Captured on a Remidio FOP fundus camera; color fundus image: 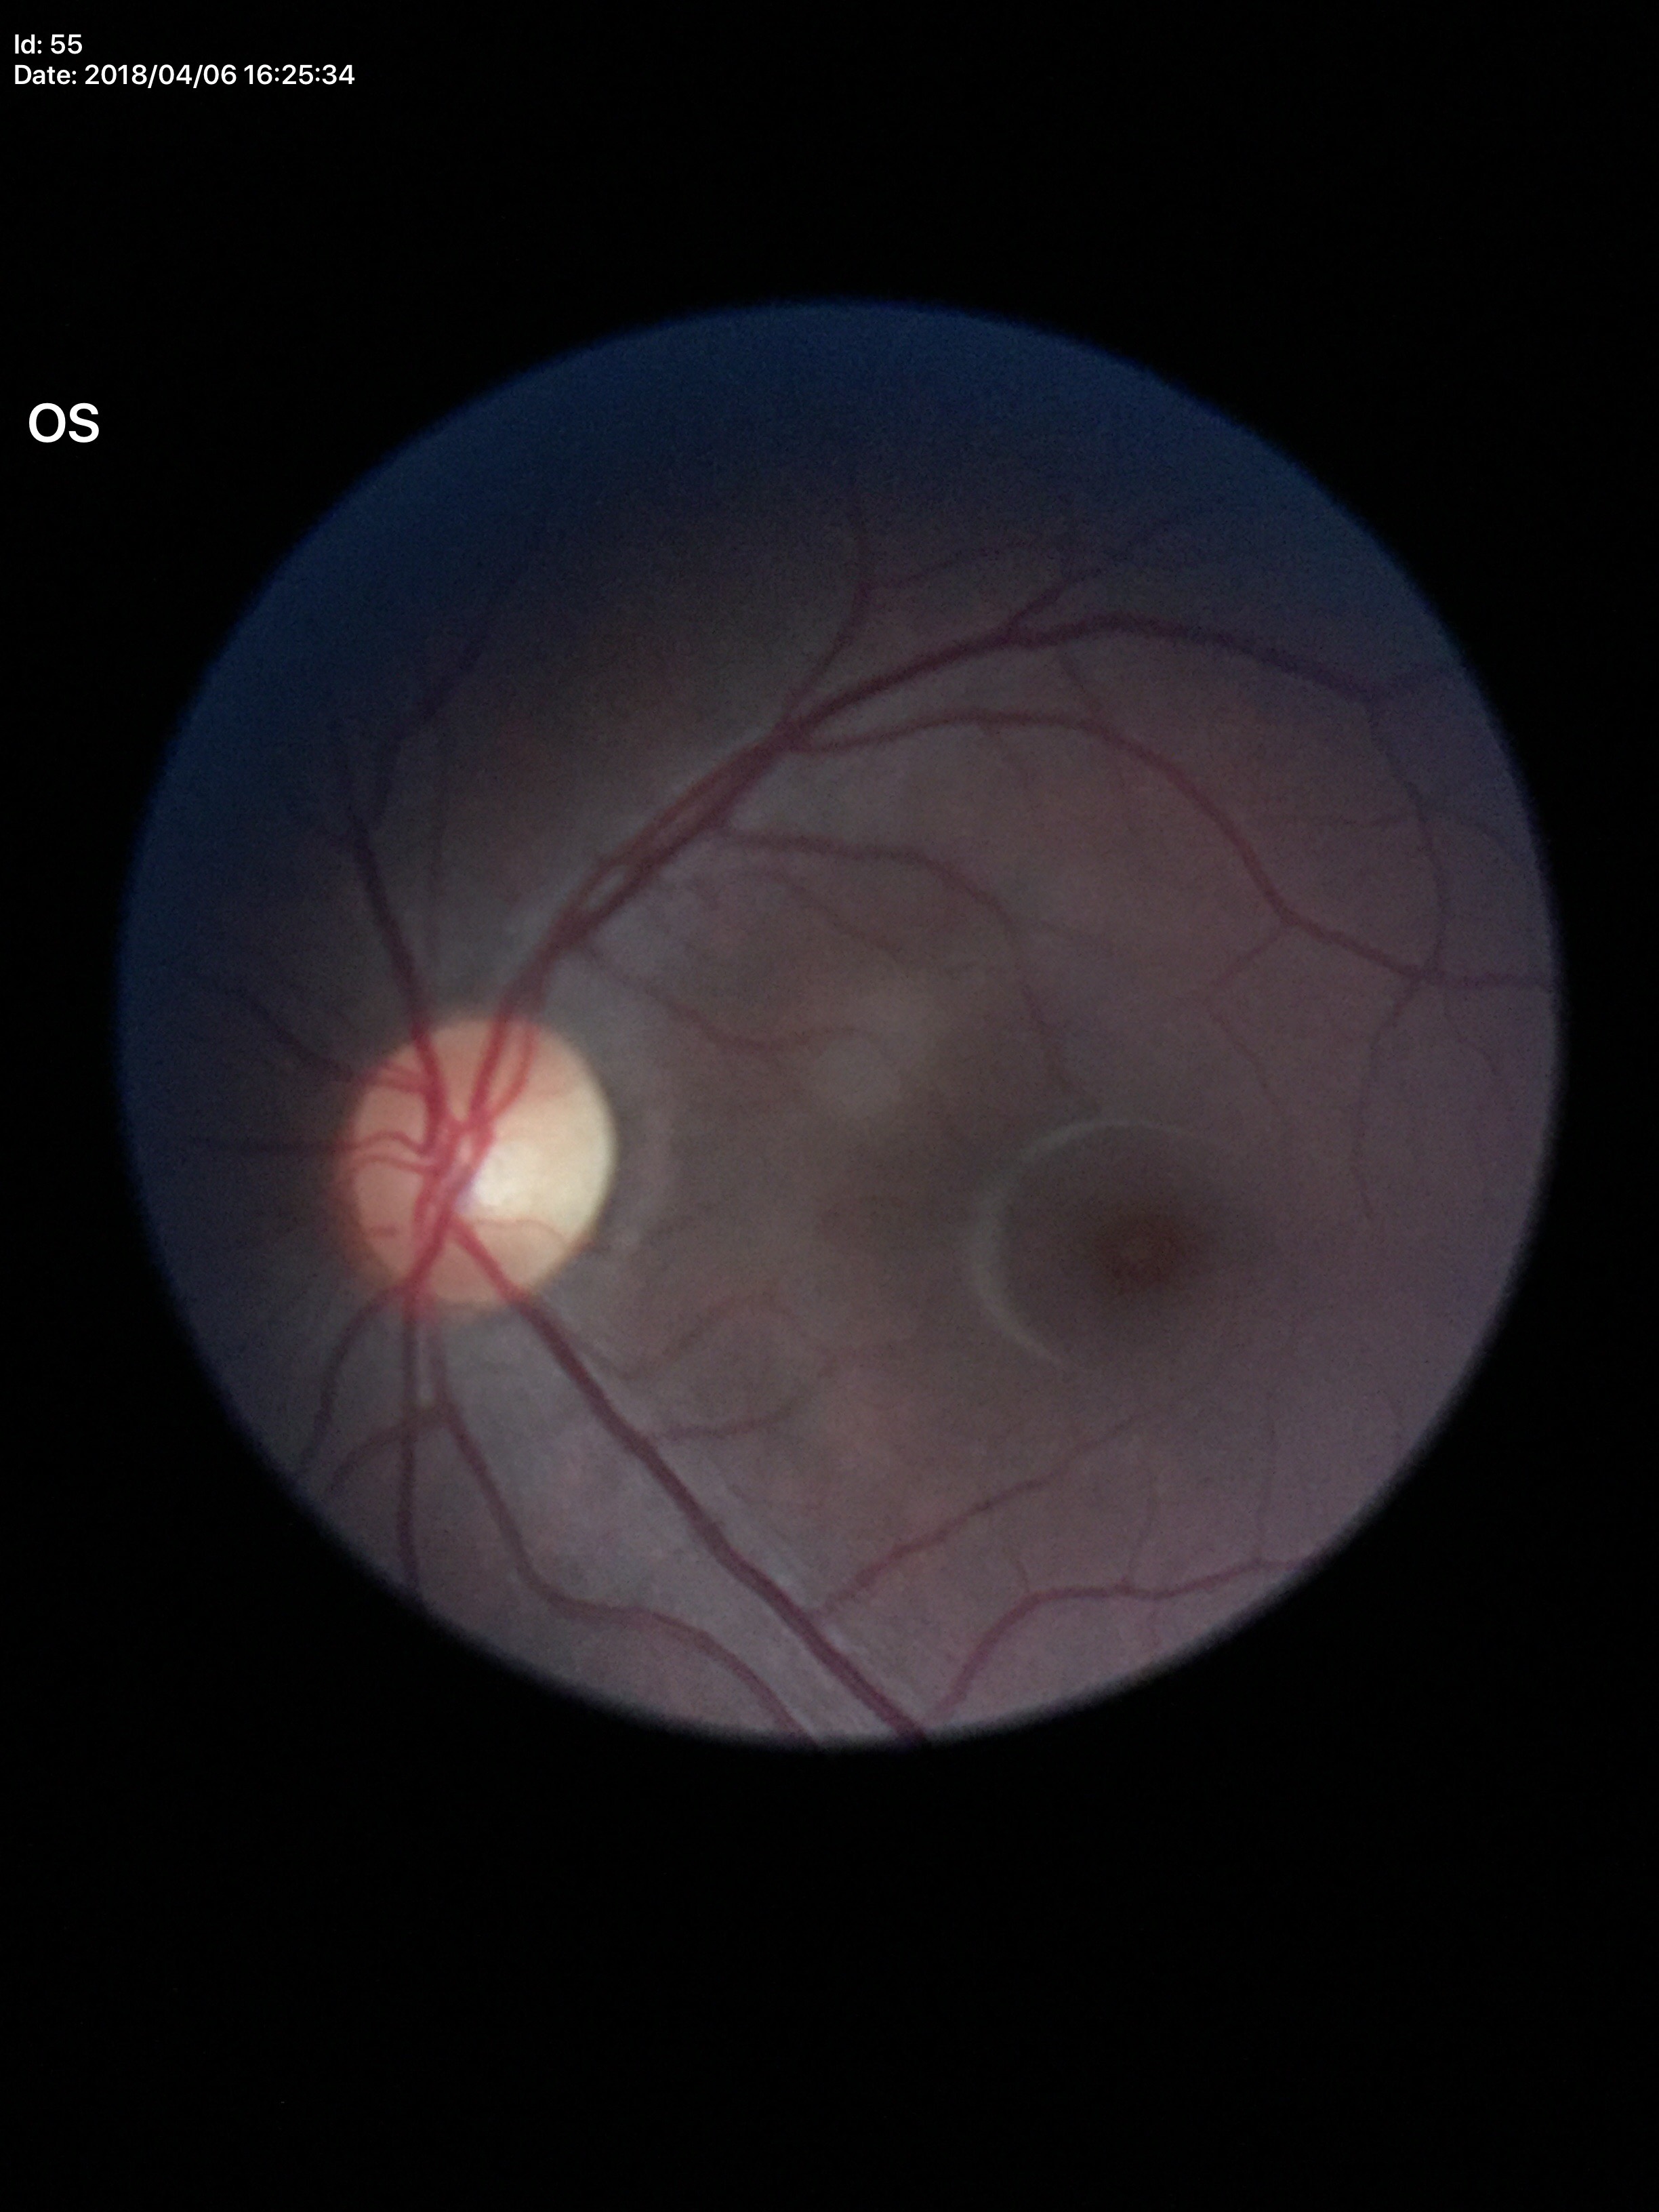

Glaucoma screening impression: not suspect. Vertical cup-disc ratio (VCDR) is 0.49. Horizontal C/D ratio (HCDR) of 0.51.